2212x1659px · FOV: 45 degrees · retinal fundus photograph: 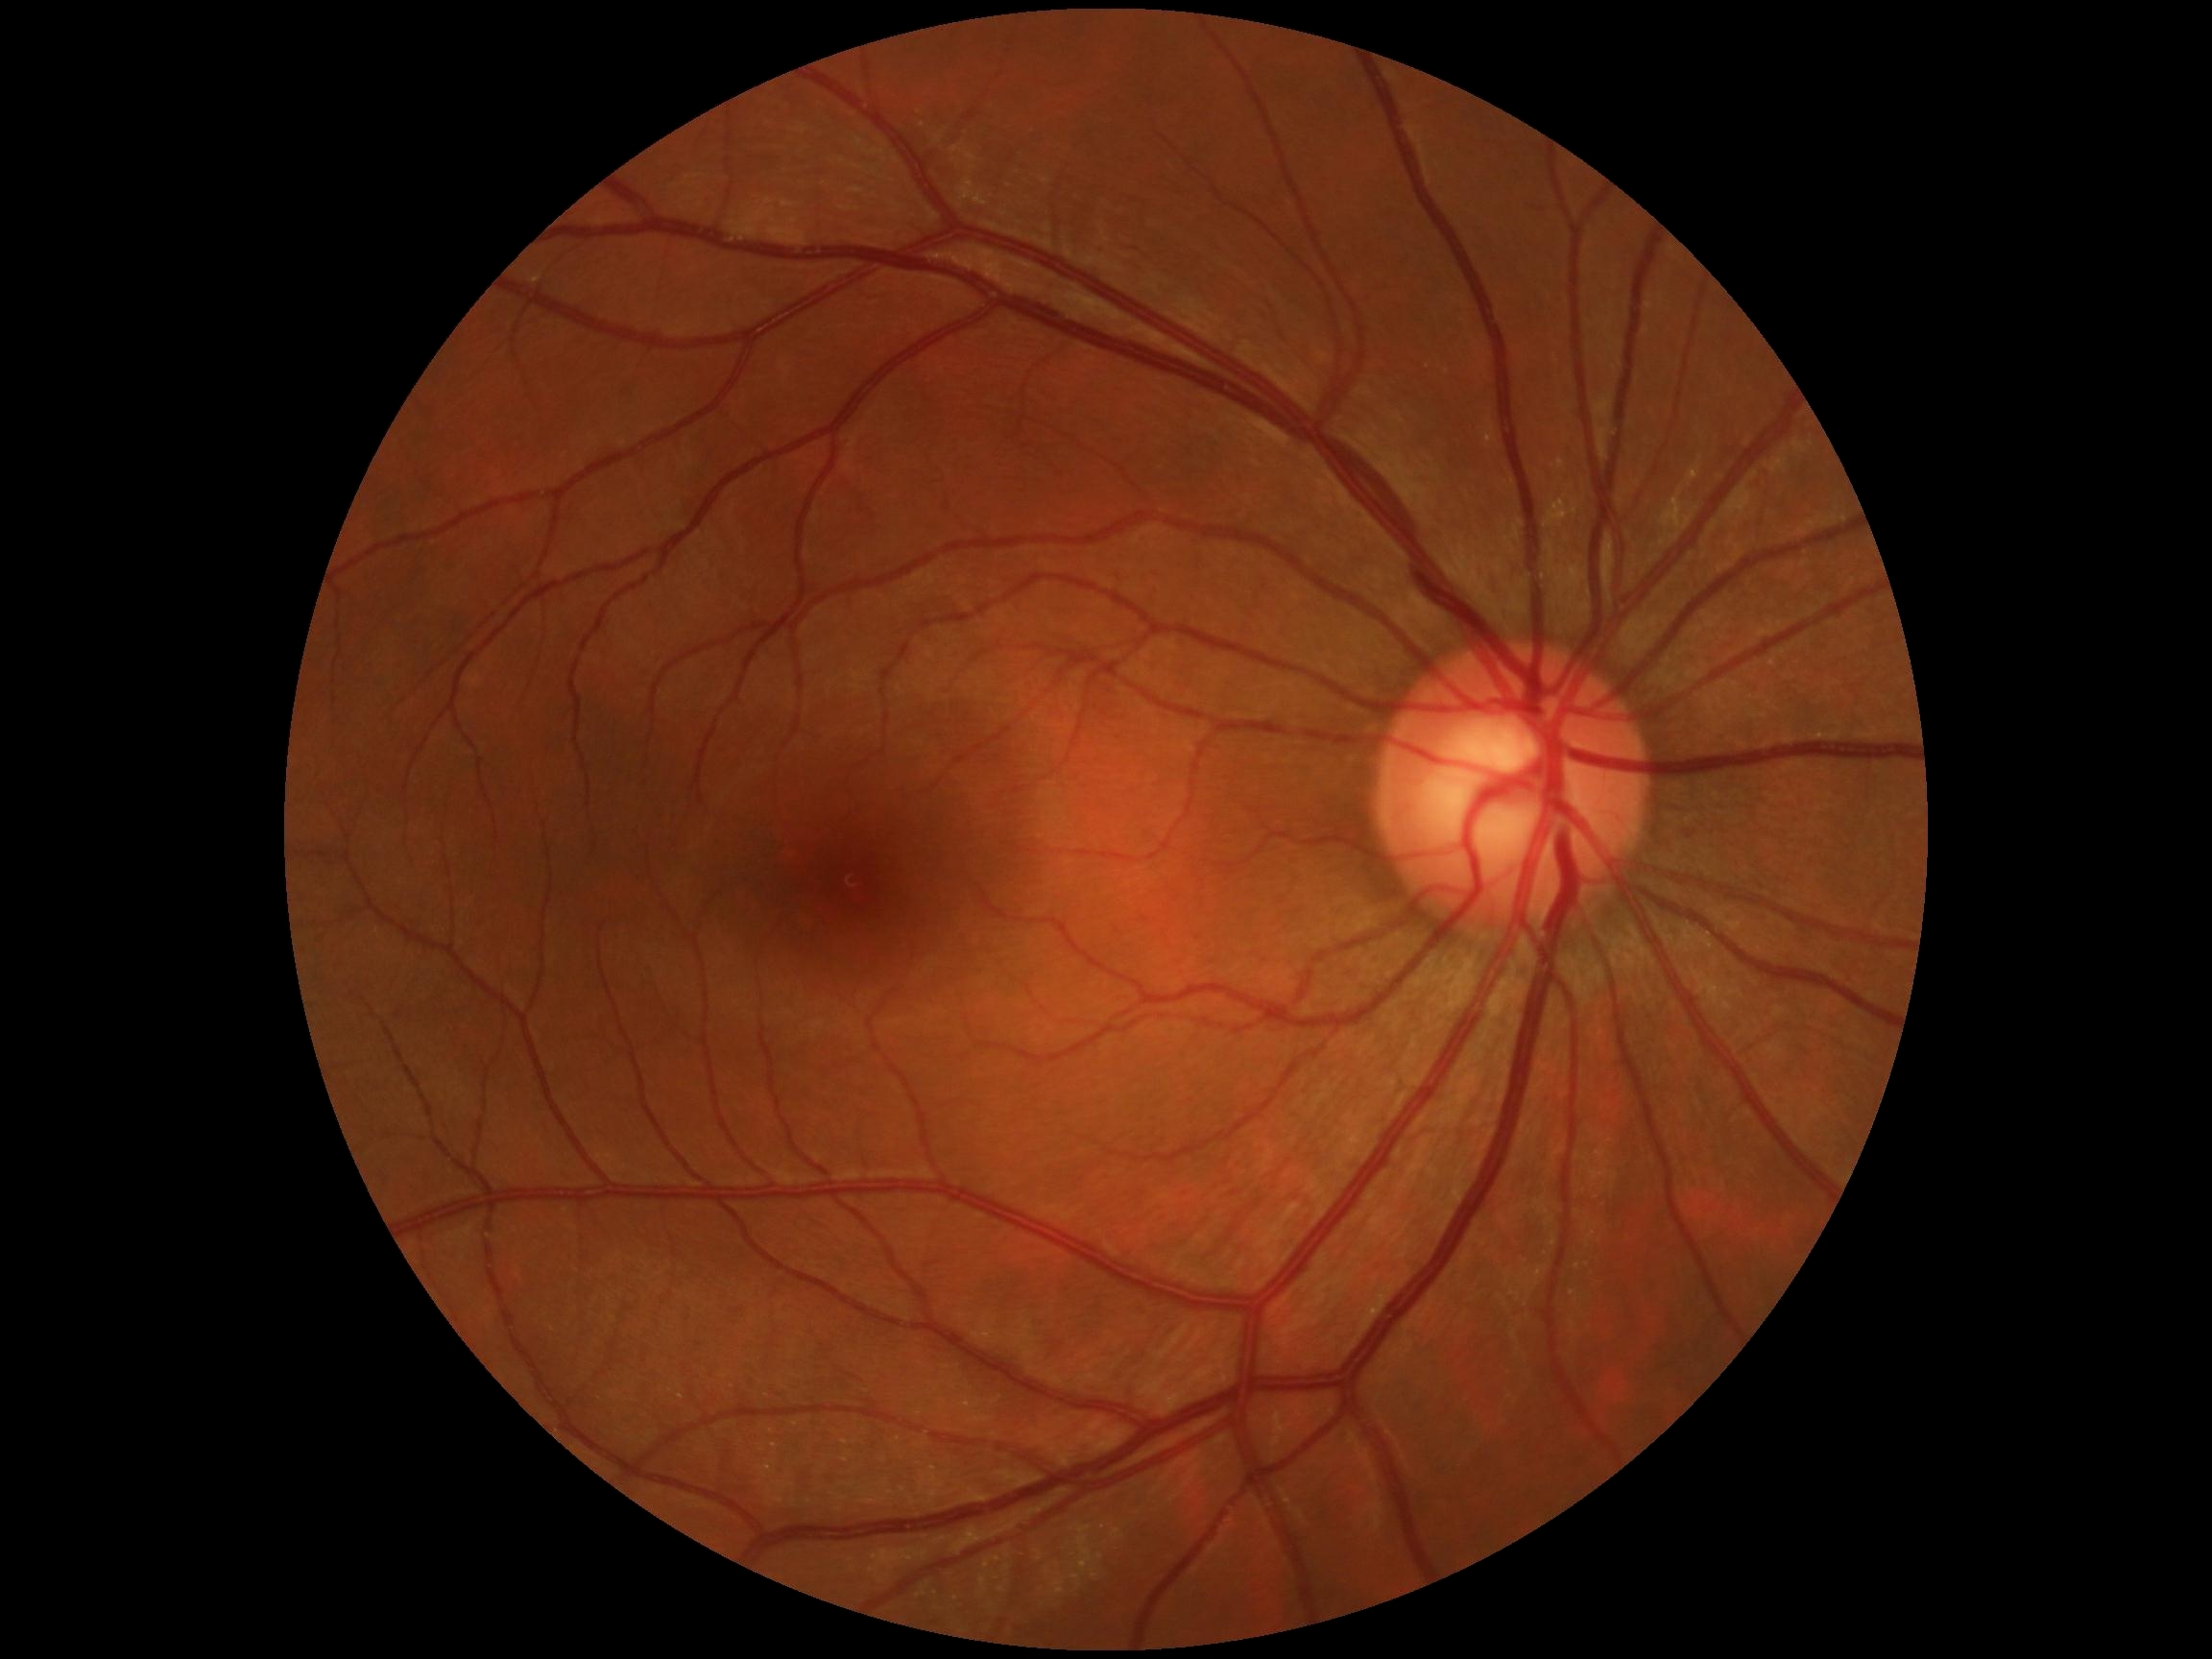 diabetic retinopathy (DR) = grade 0 (no apparent retinopathy).